Retinal fundus photograph, image size 1470x1137: 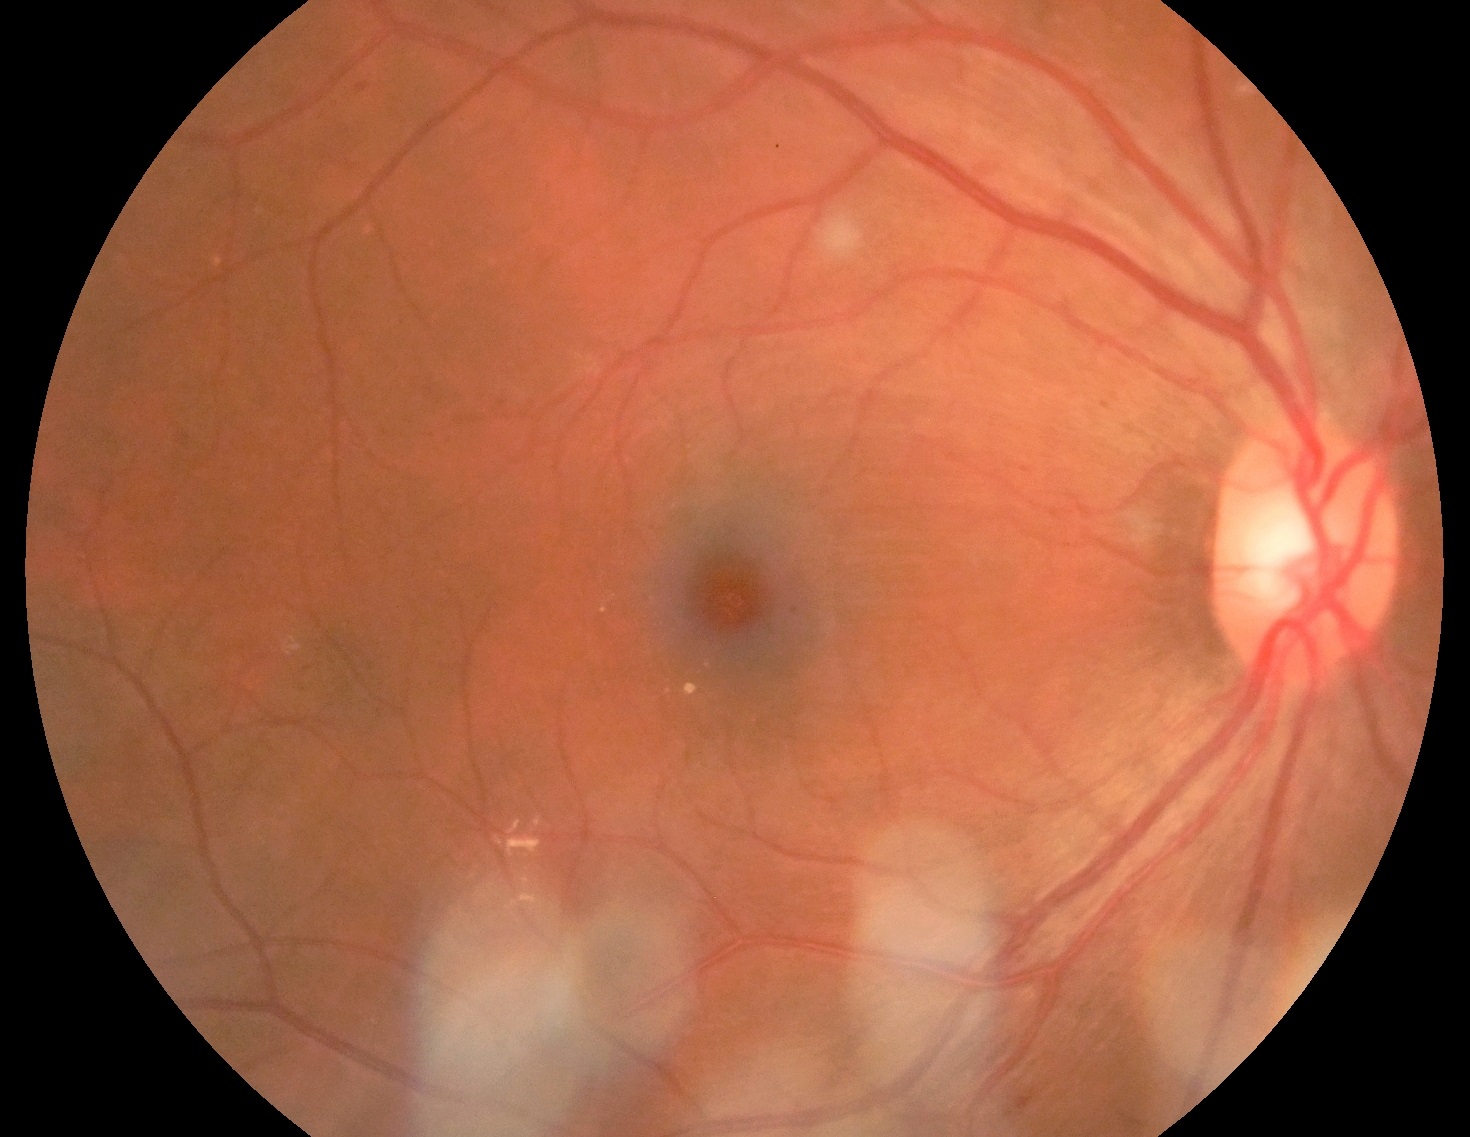
Diabetic retinopathy (DR) is moderate NPDR (grade 2).
The retinopathy is classified as non-proliferative diabetic retinopathy.